CFP; 45° FOV — 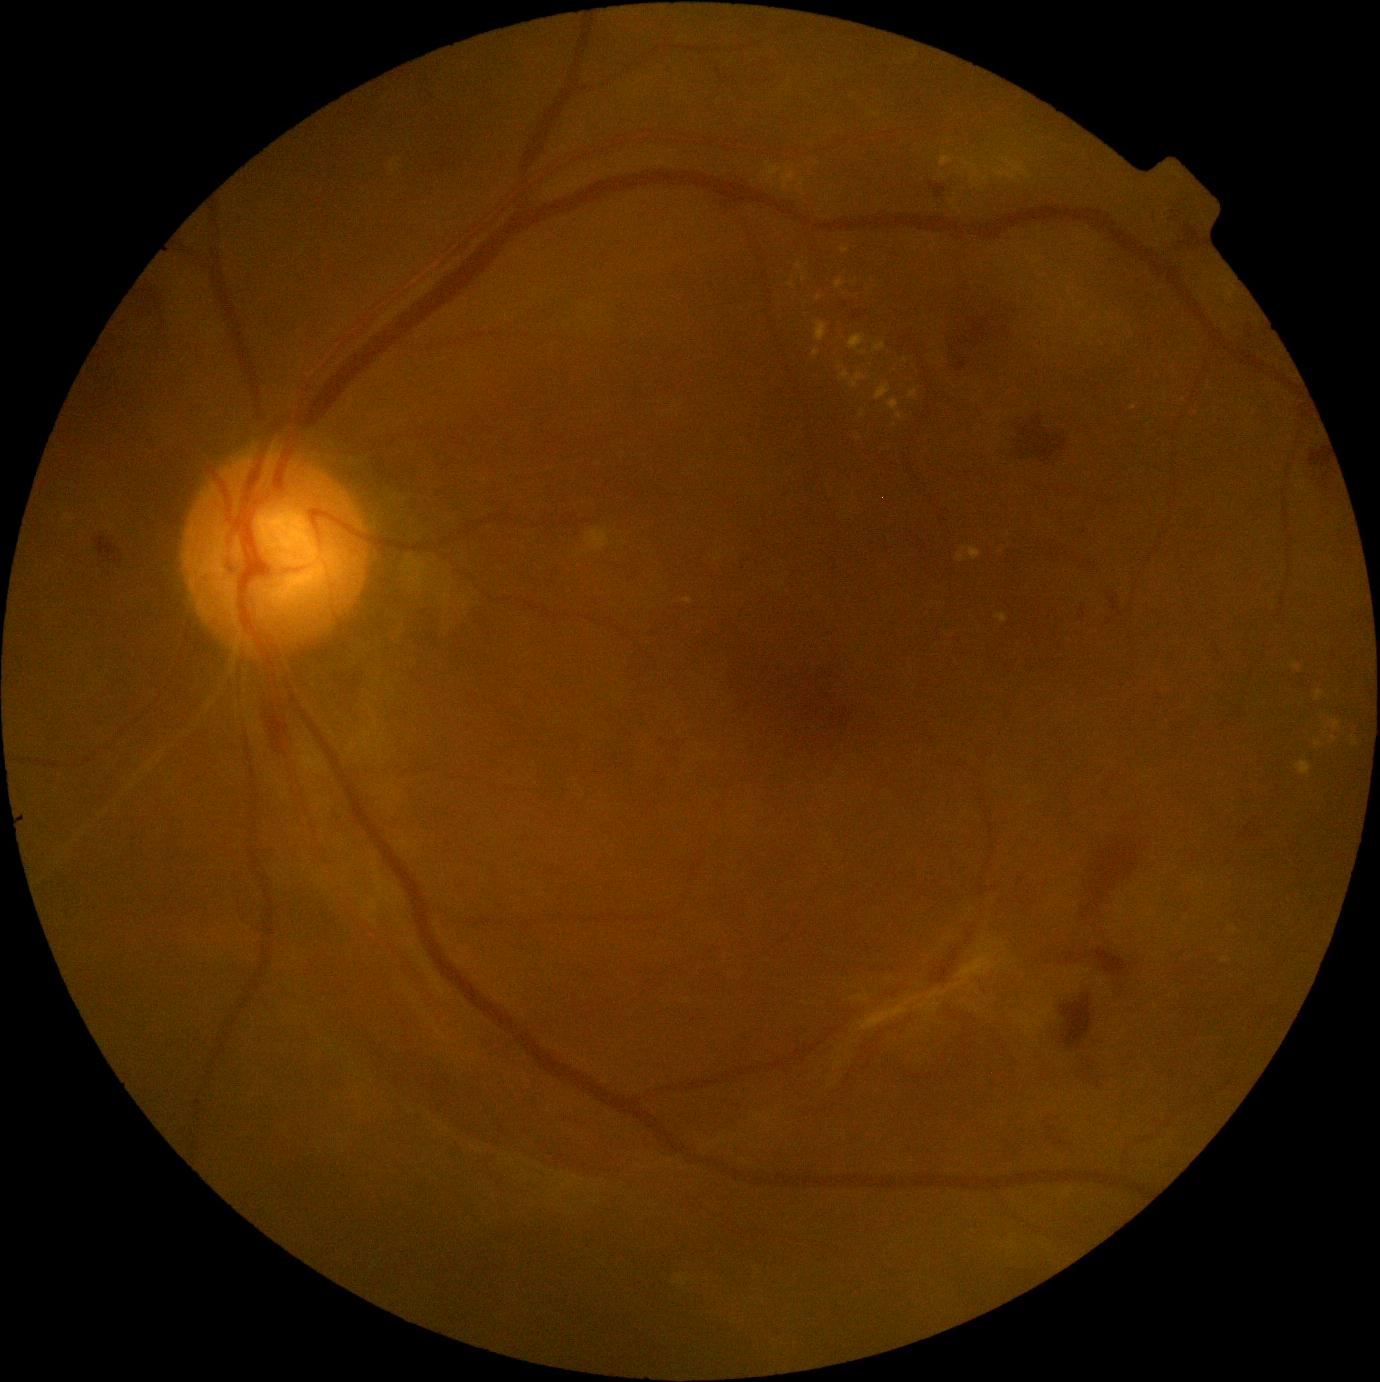

DR stage is proliferative diabetic retinopathy (grade 4).
EXs include 849, 336, 866, 350 | 909, 390, 918, 399 | 836, 279, 847, 290 | 932, 243, 938, 251 | 1297, 761, 1311, 776 | 940, 156, 953, 167 | 782, 167, 797, 190 | 1315, 691, 1325, 702 | 813, 350, 821, 357 | 682, 598, 692, 605.
Additional small EXs near point(791, 285) | point(865, 354) | point(944, 176) | point(986, 179).